45 degree fundus photograph; CFP; camera: NIDEK AFC-230; 848x848: 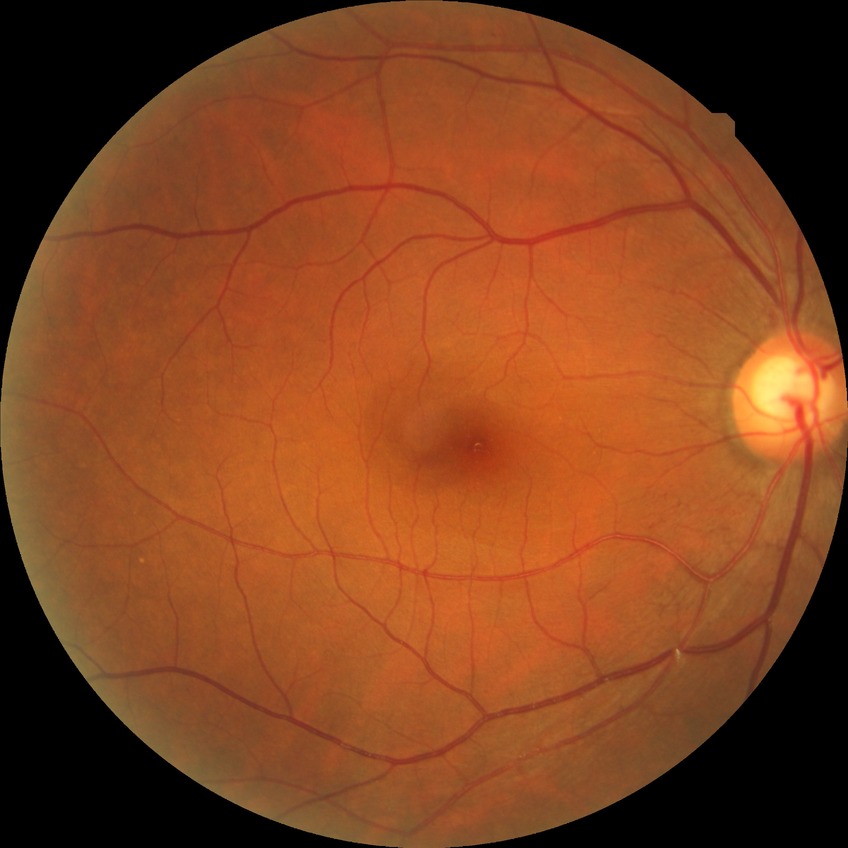 {"davis_grade": "no diabetic retinopathy"}